45° field of view · acquired with a NIDEK AFC-230 · modified Davis classification.
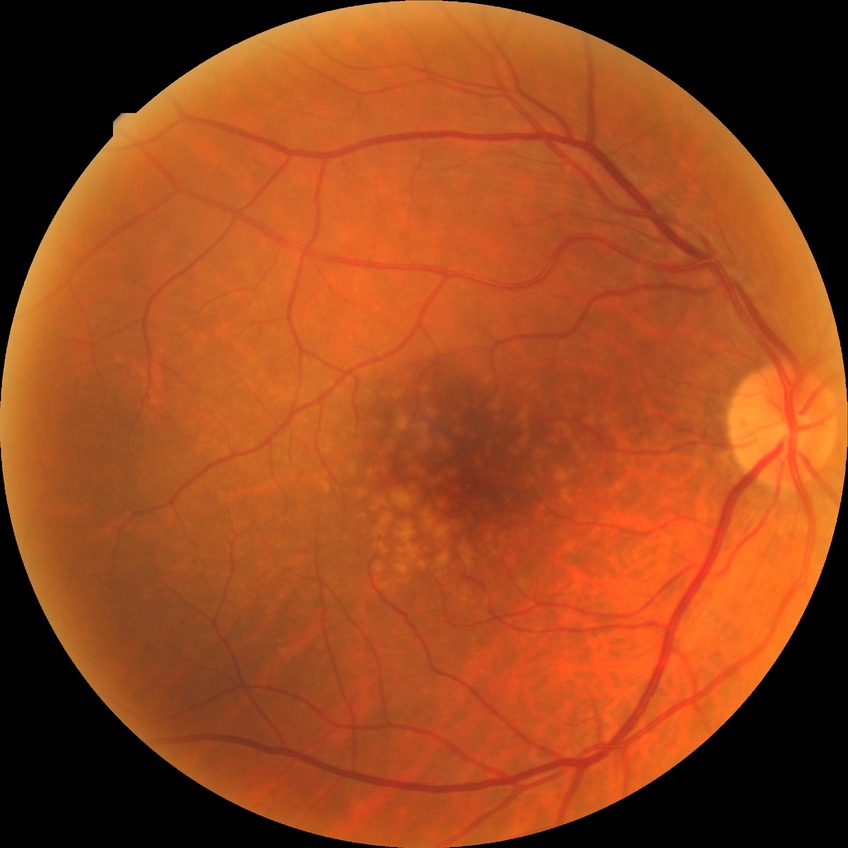 Davis grading: no diabetic retinopathy.